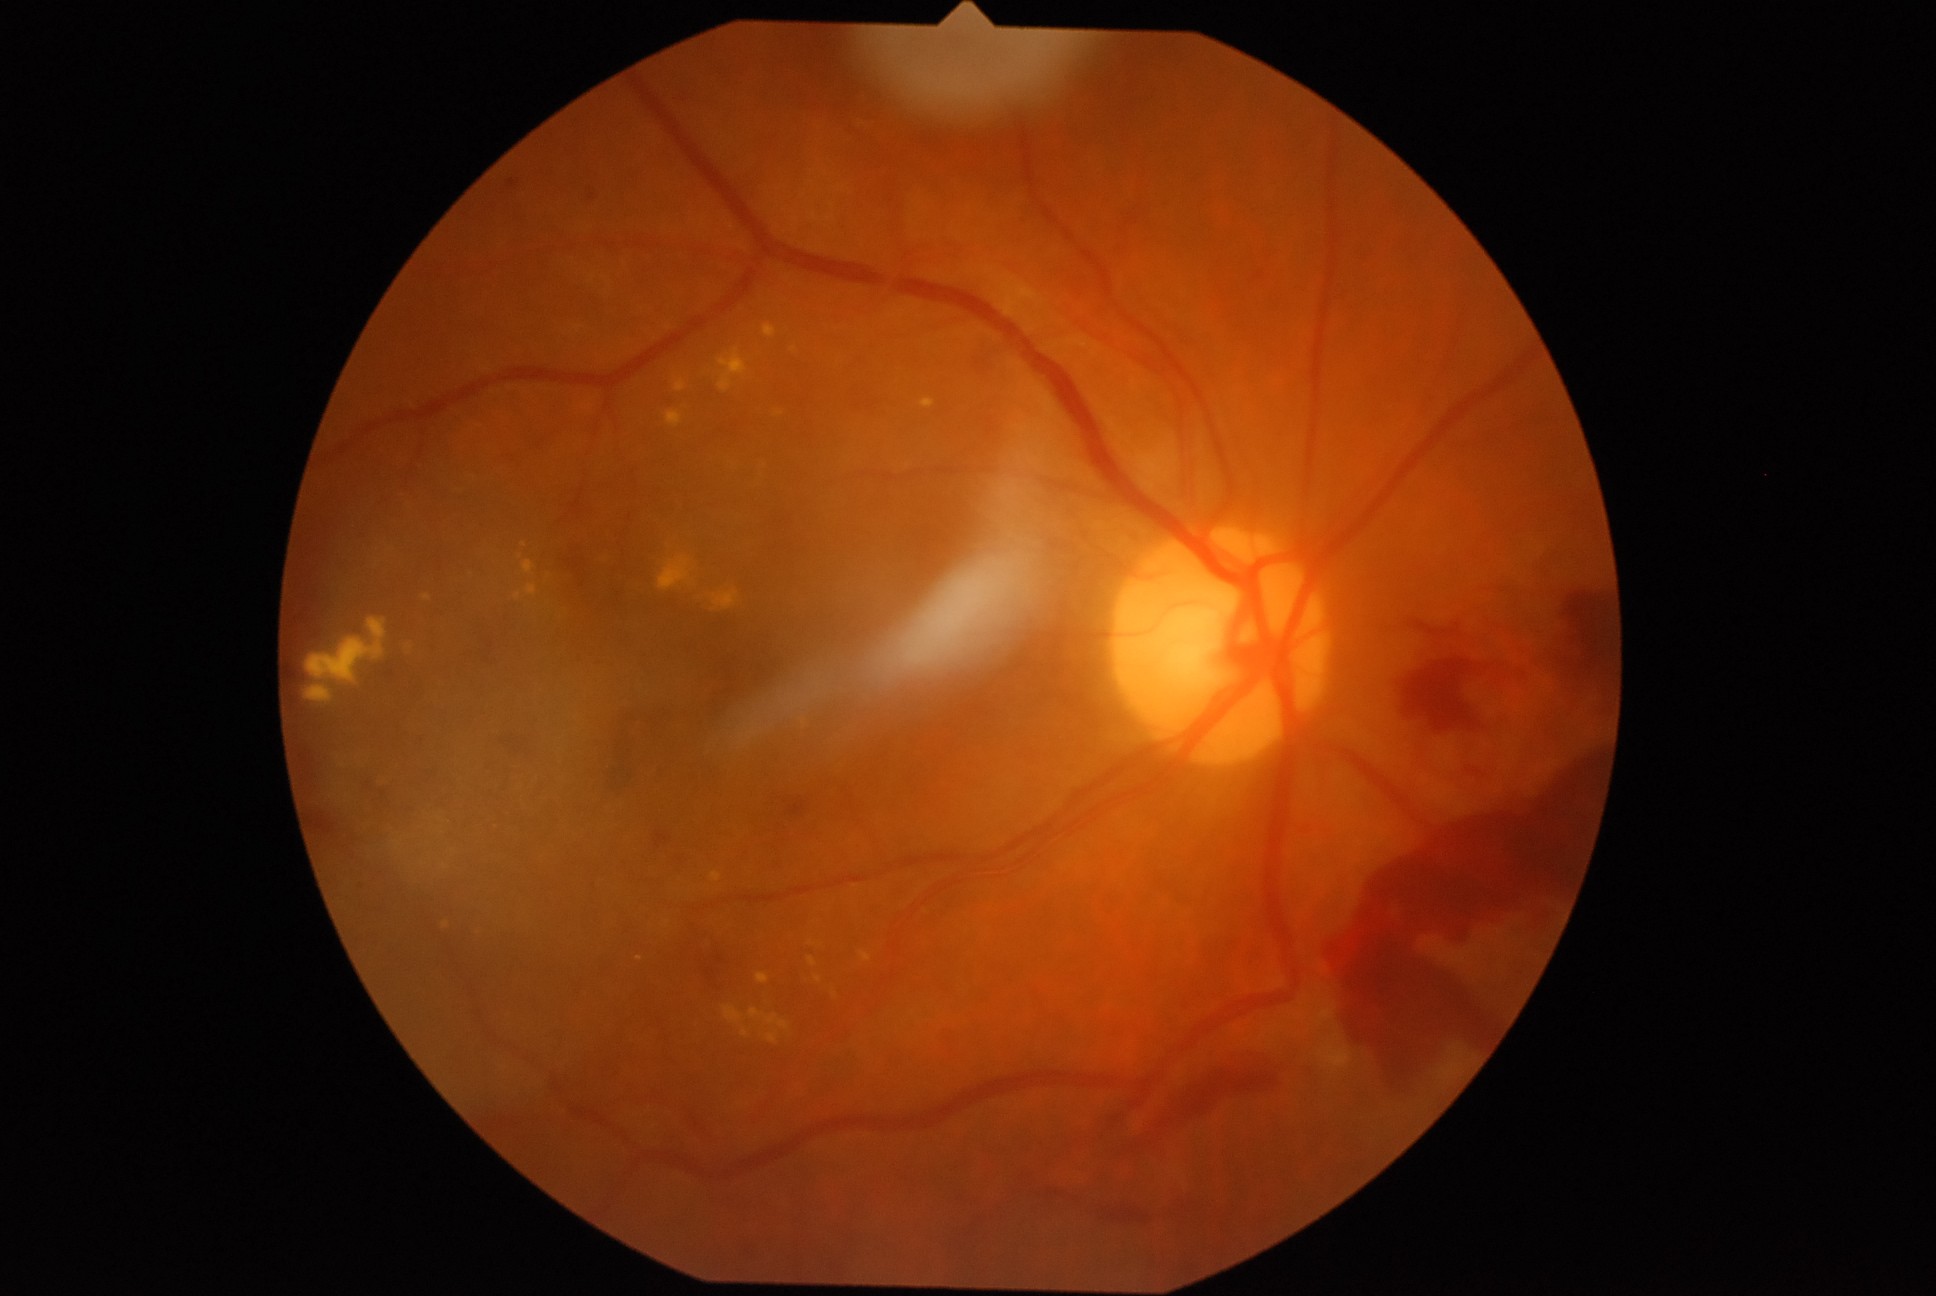
diabetic retinopathy (DR): proliferative diabetic retinopathy (grade 4).